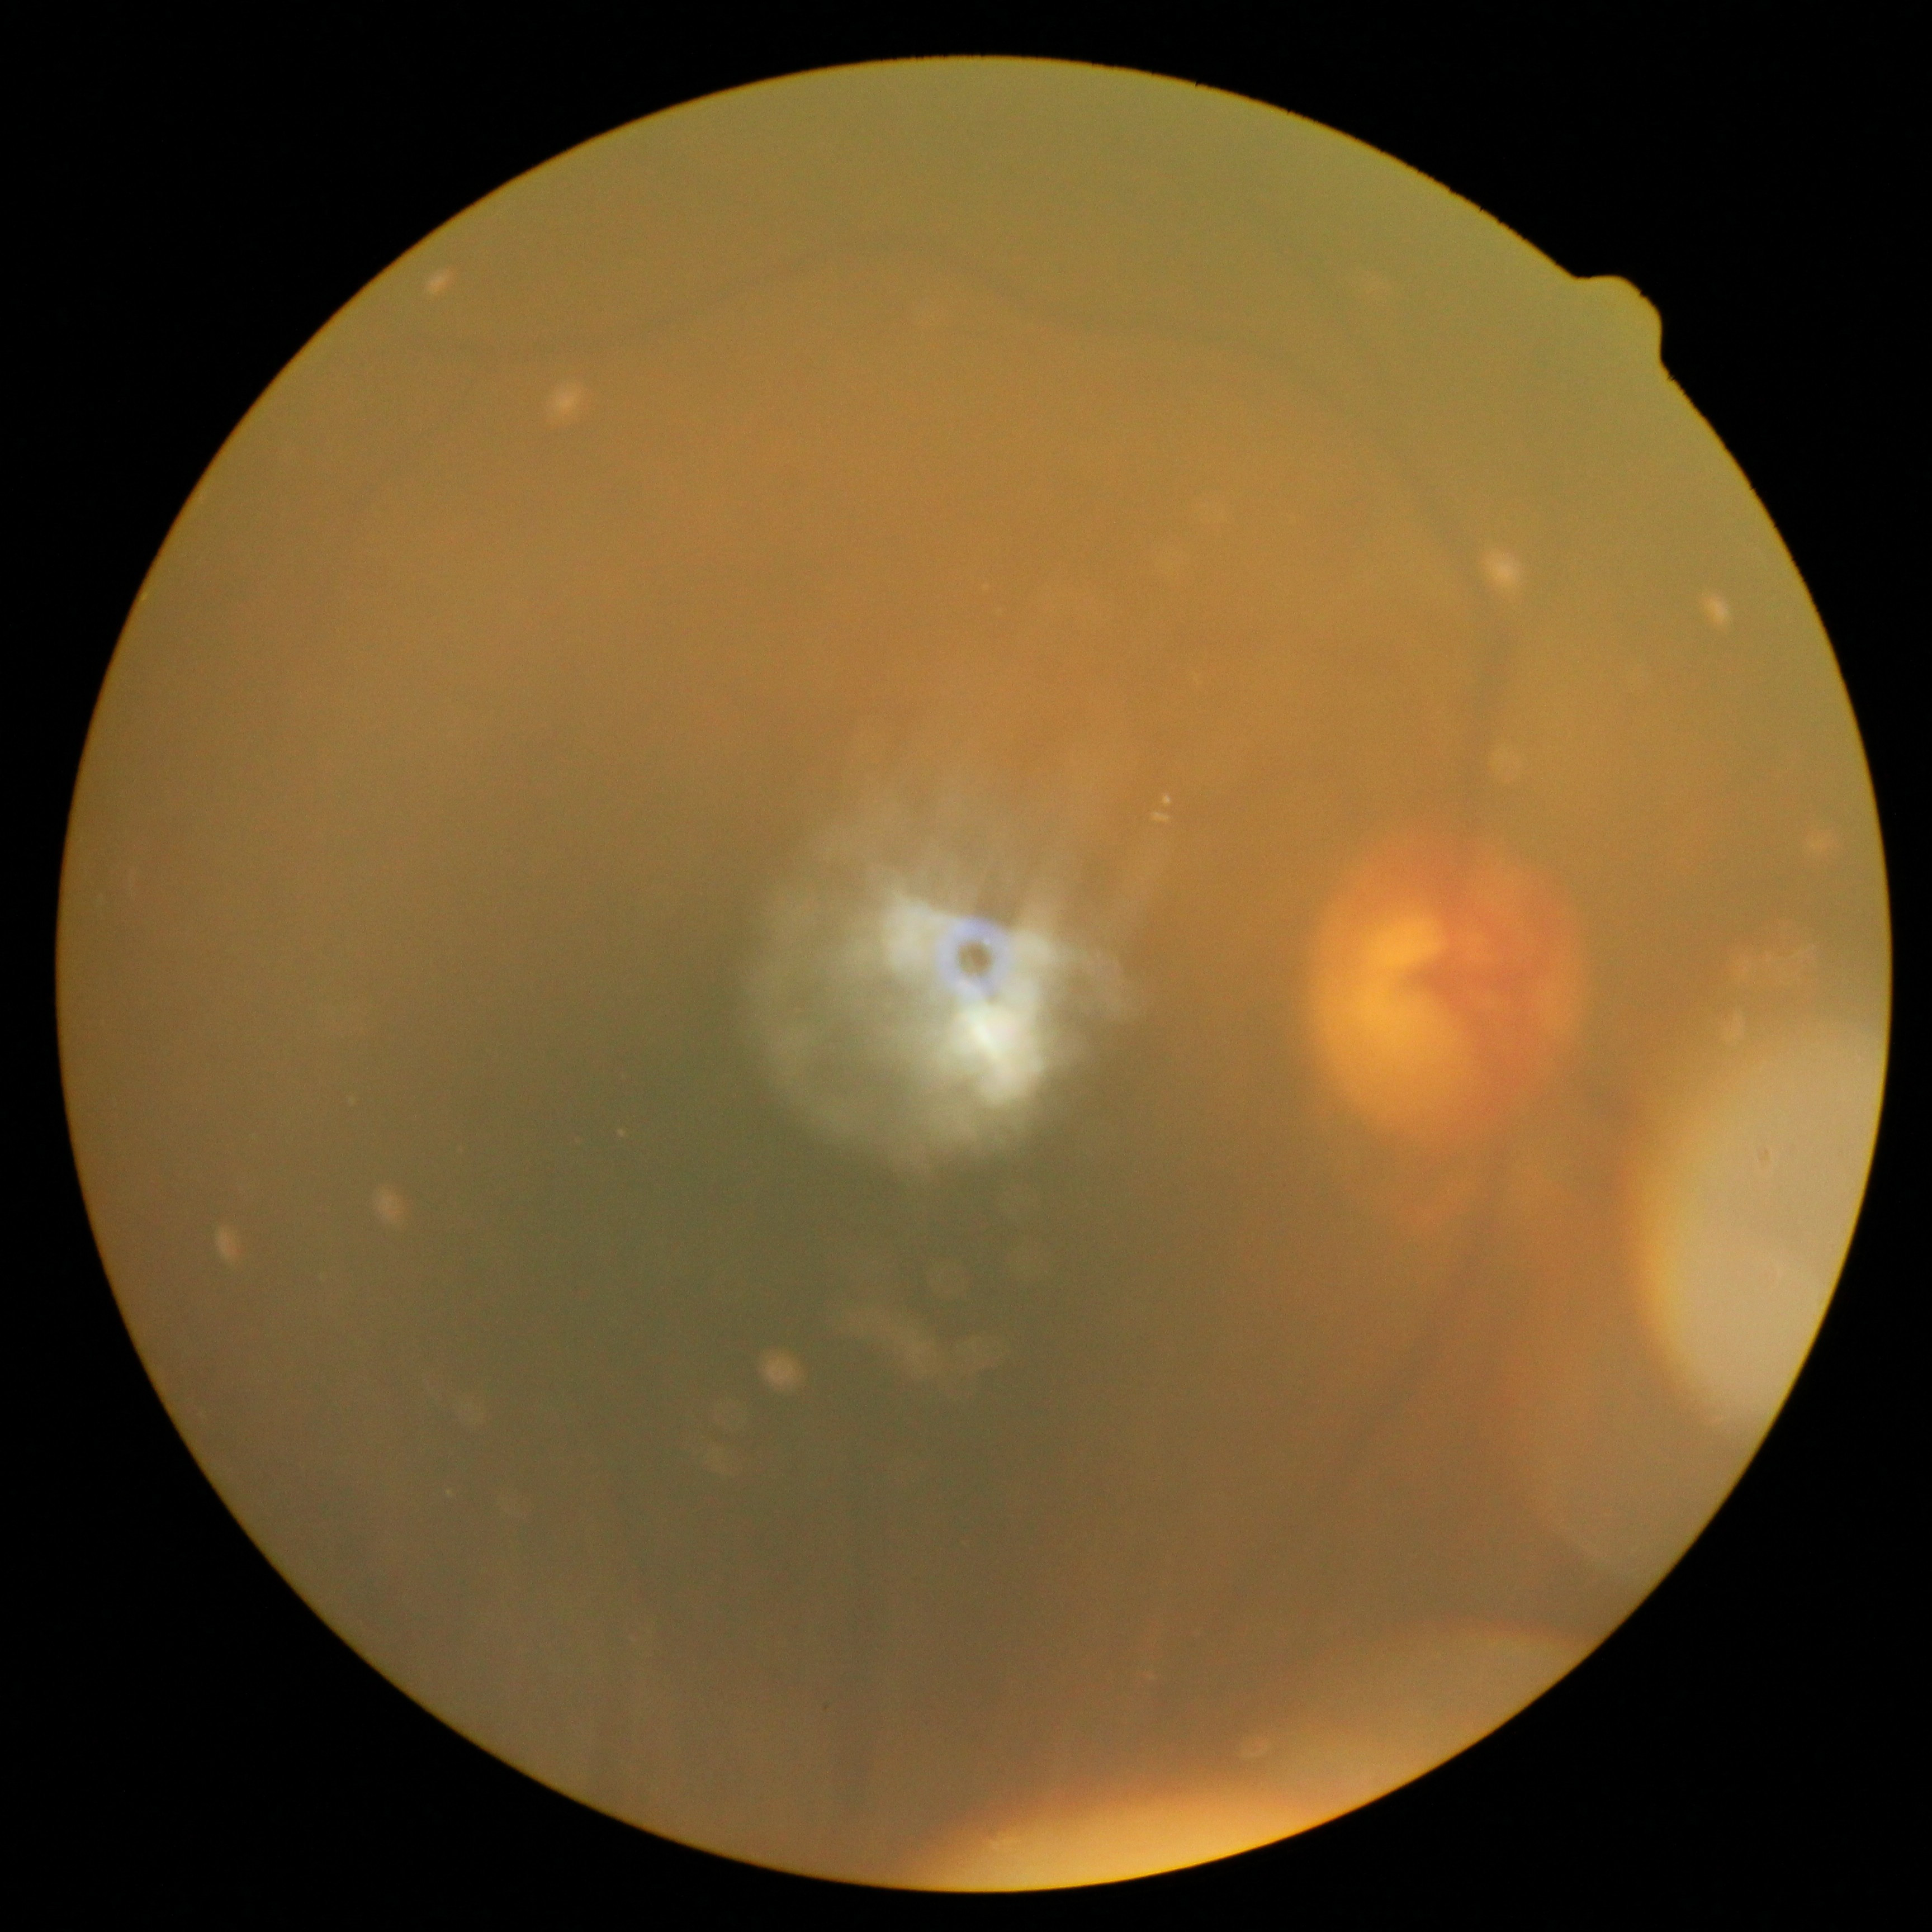 DR grade: ungradable due to poor image quality.